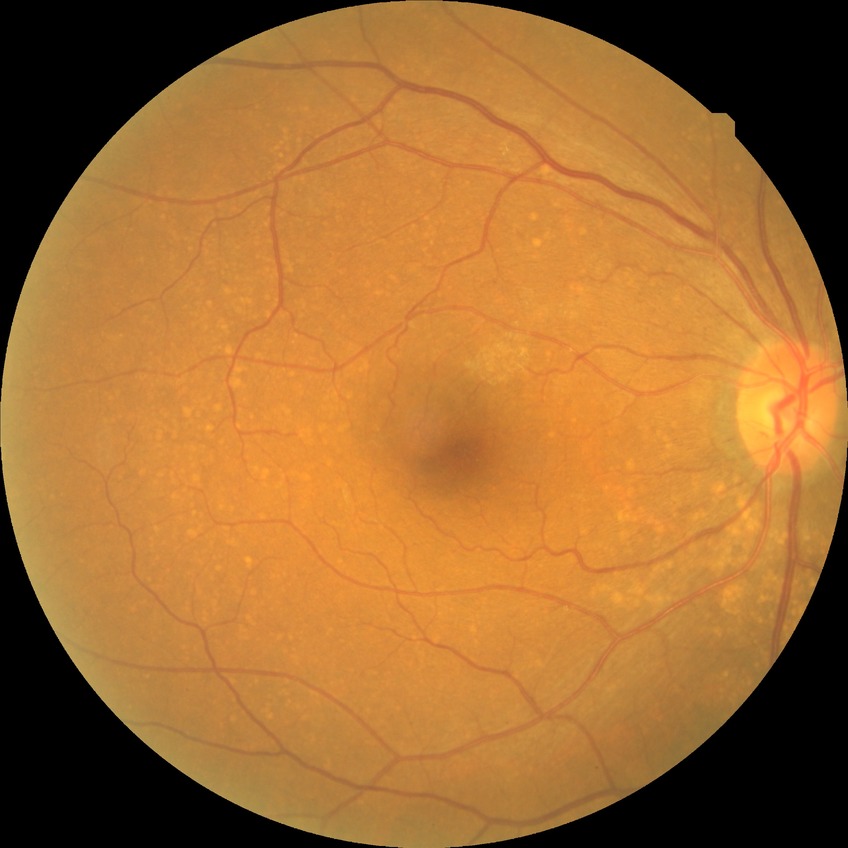

Modified Davis grade: SDR.